Fundus photo — 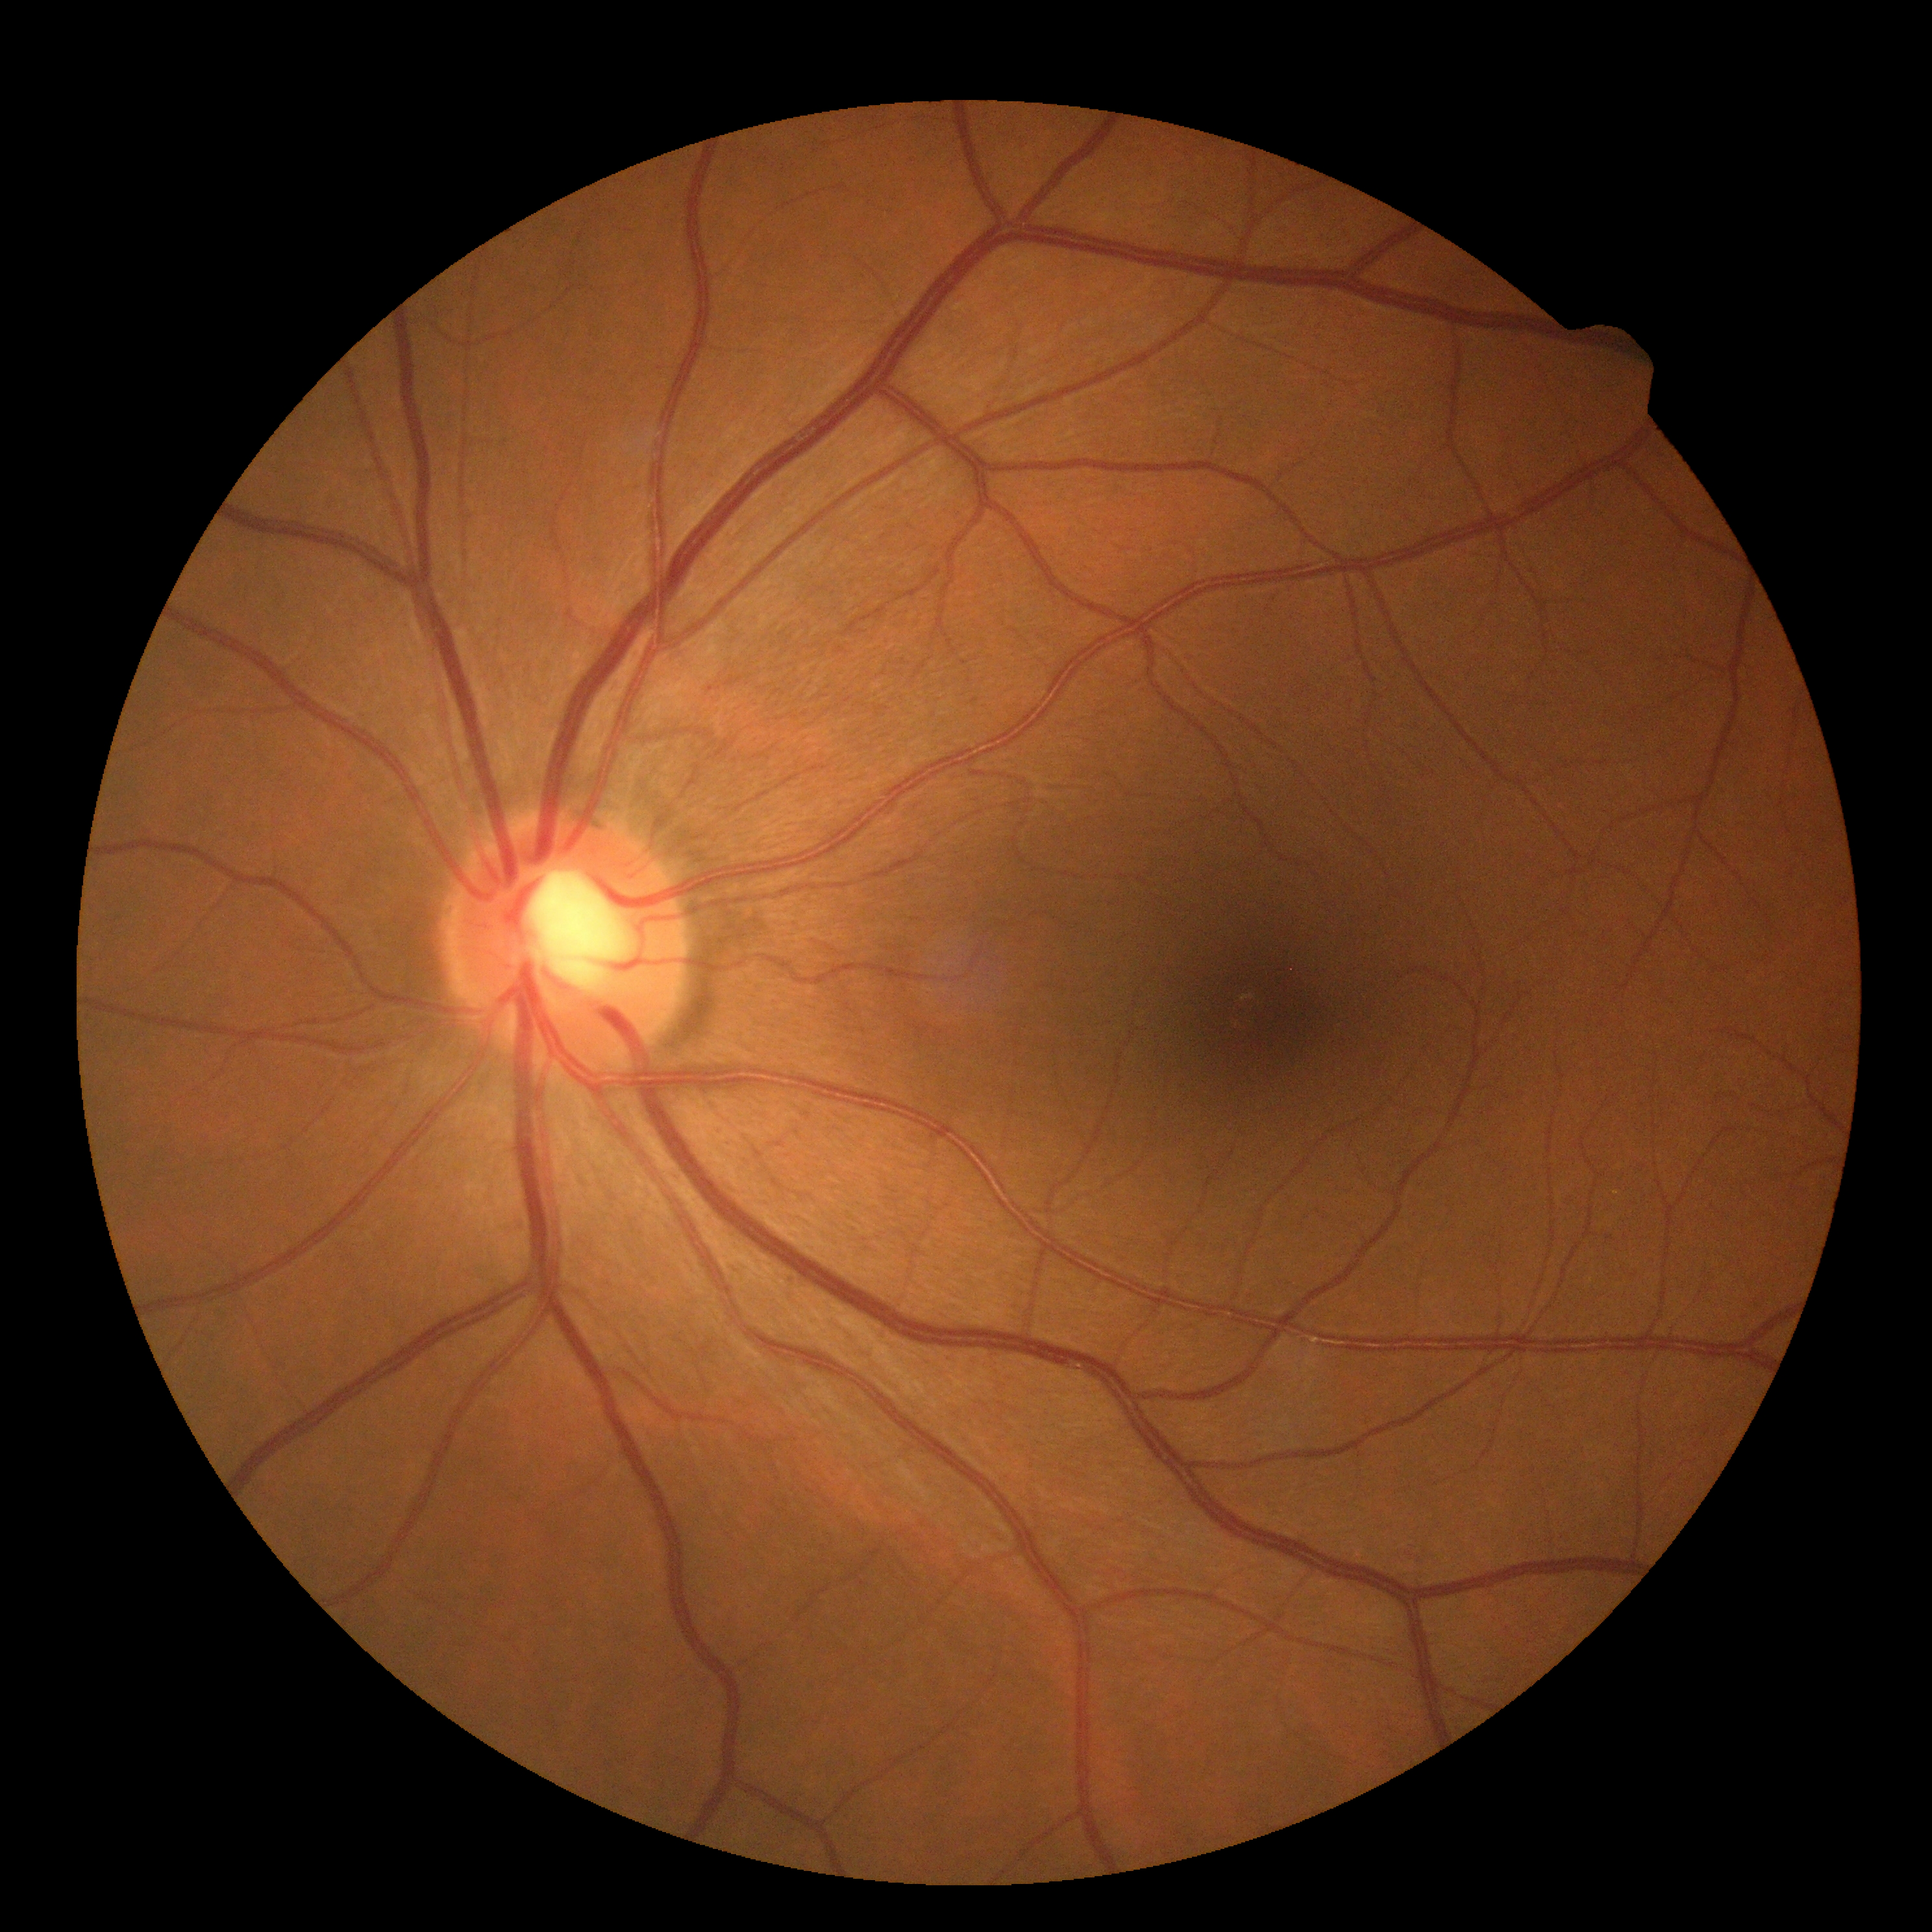
DR stage: 0 — no visible signs of diabetic retinopathy.
No signs of diabetic retinopathy.